130° field of view (Clarity RetCam 3) · wide-field fundus photograph from neonatal ROP screening · 640x480: 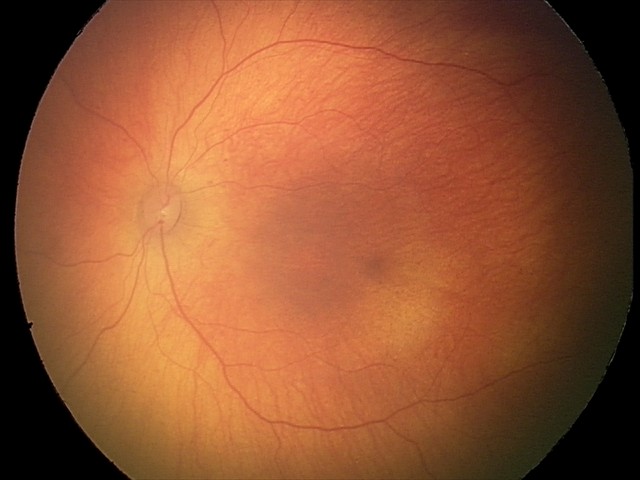 No retinal pathology identified on screening.